640x480px. Camera: Clarity RetCam 3 (130° FOV). Infant wide-field fundus photograph.
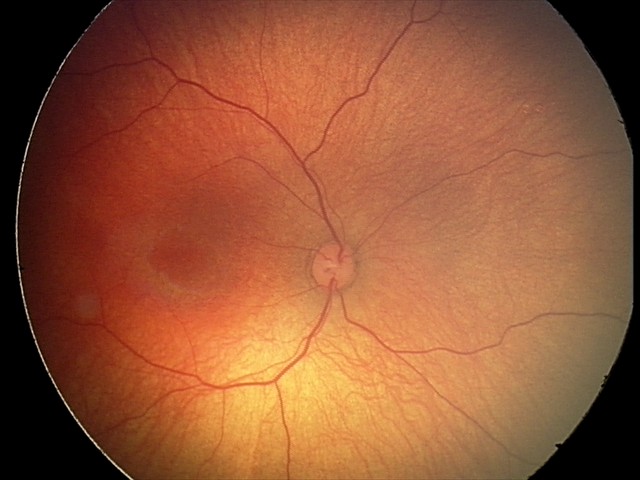
Screening diagnosis: physiological finding.